848 x 848 pixels, acquired with a NIDEK AFC-230, 45° FOV.
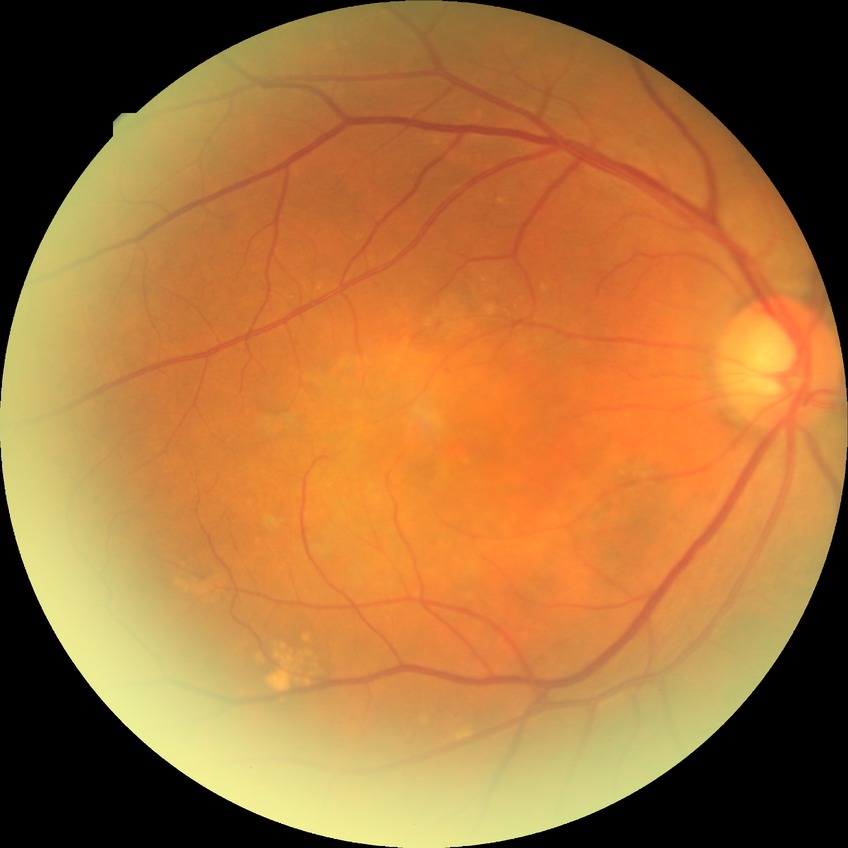
{
  "davis_grade": "simple diabetic retinopathy"
}